Wide-field contact fundus photograph of an infant; Clarity RetCam 3, 130° FOV.
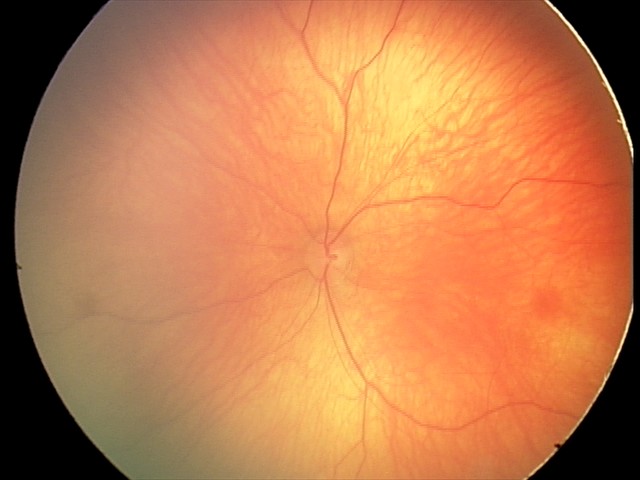
Assessment: normal